Non-mydriatic fundus camera. 240x240:
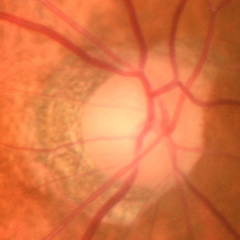 Findings consistent with glaucoma. Fundus appearance consistent with early-stage glaucoma.